Image size 2352x1568: 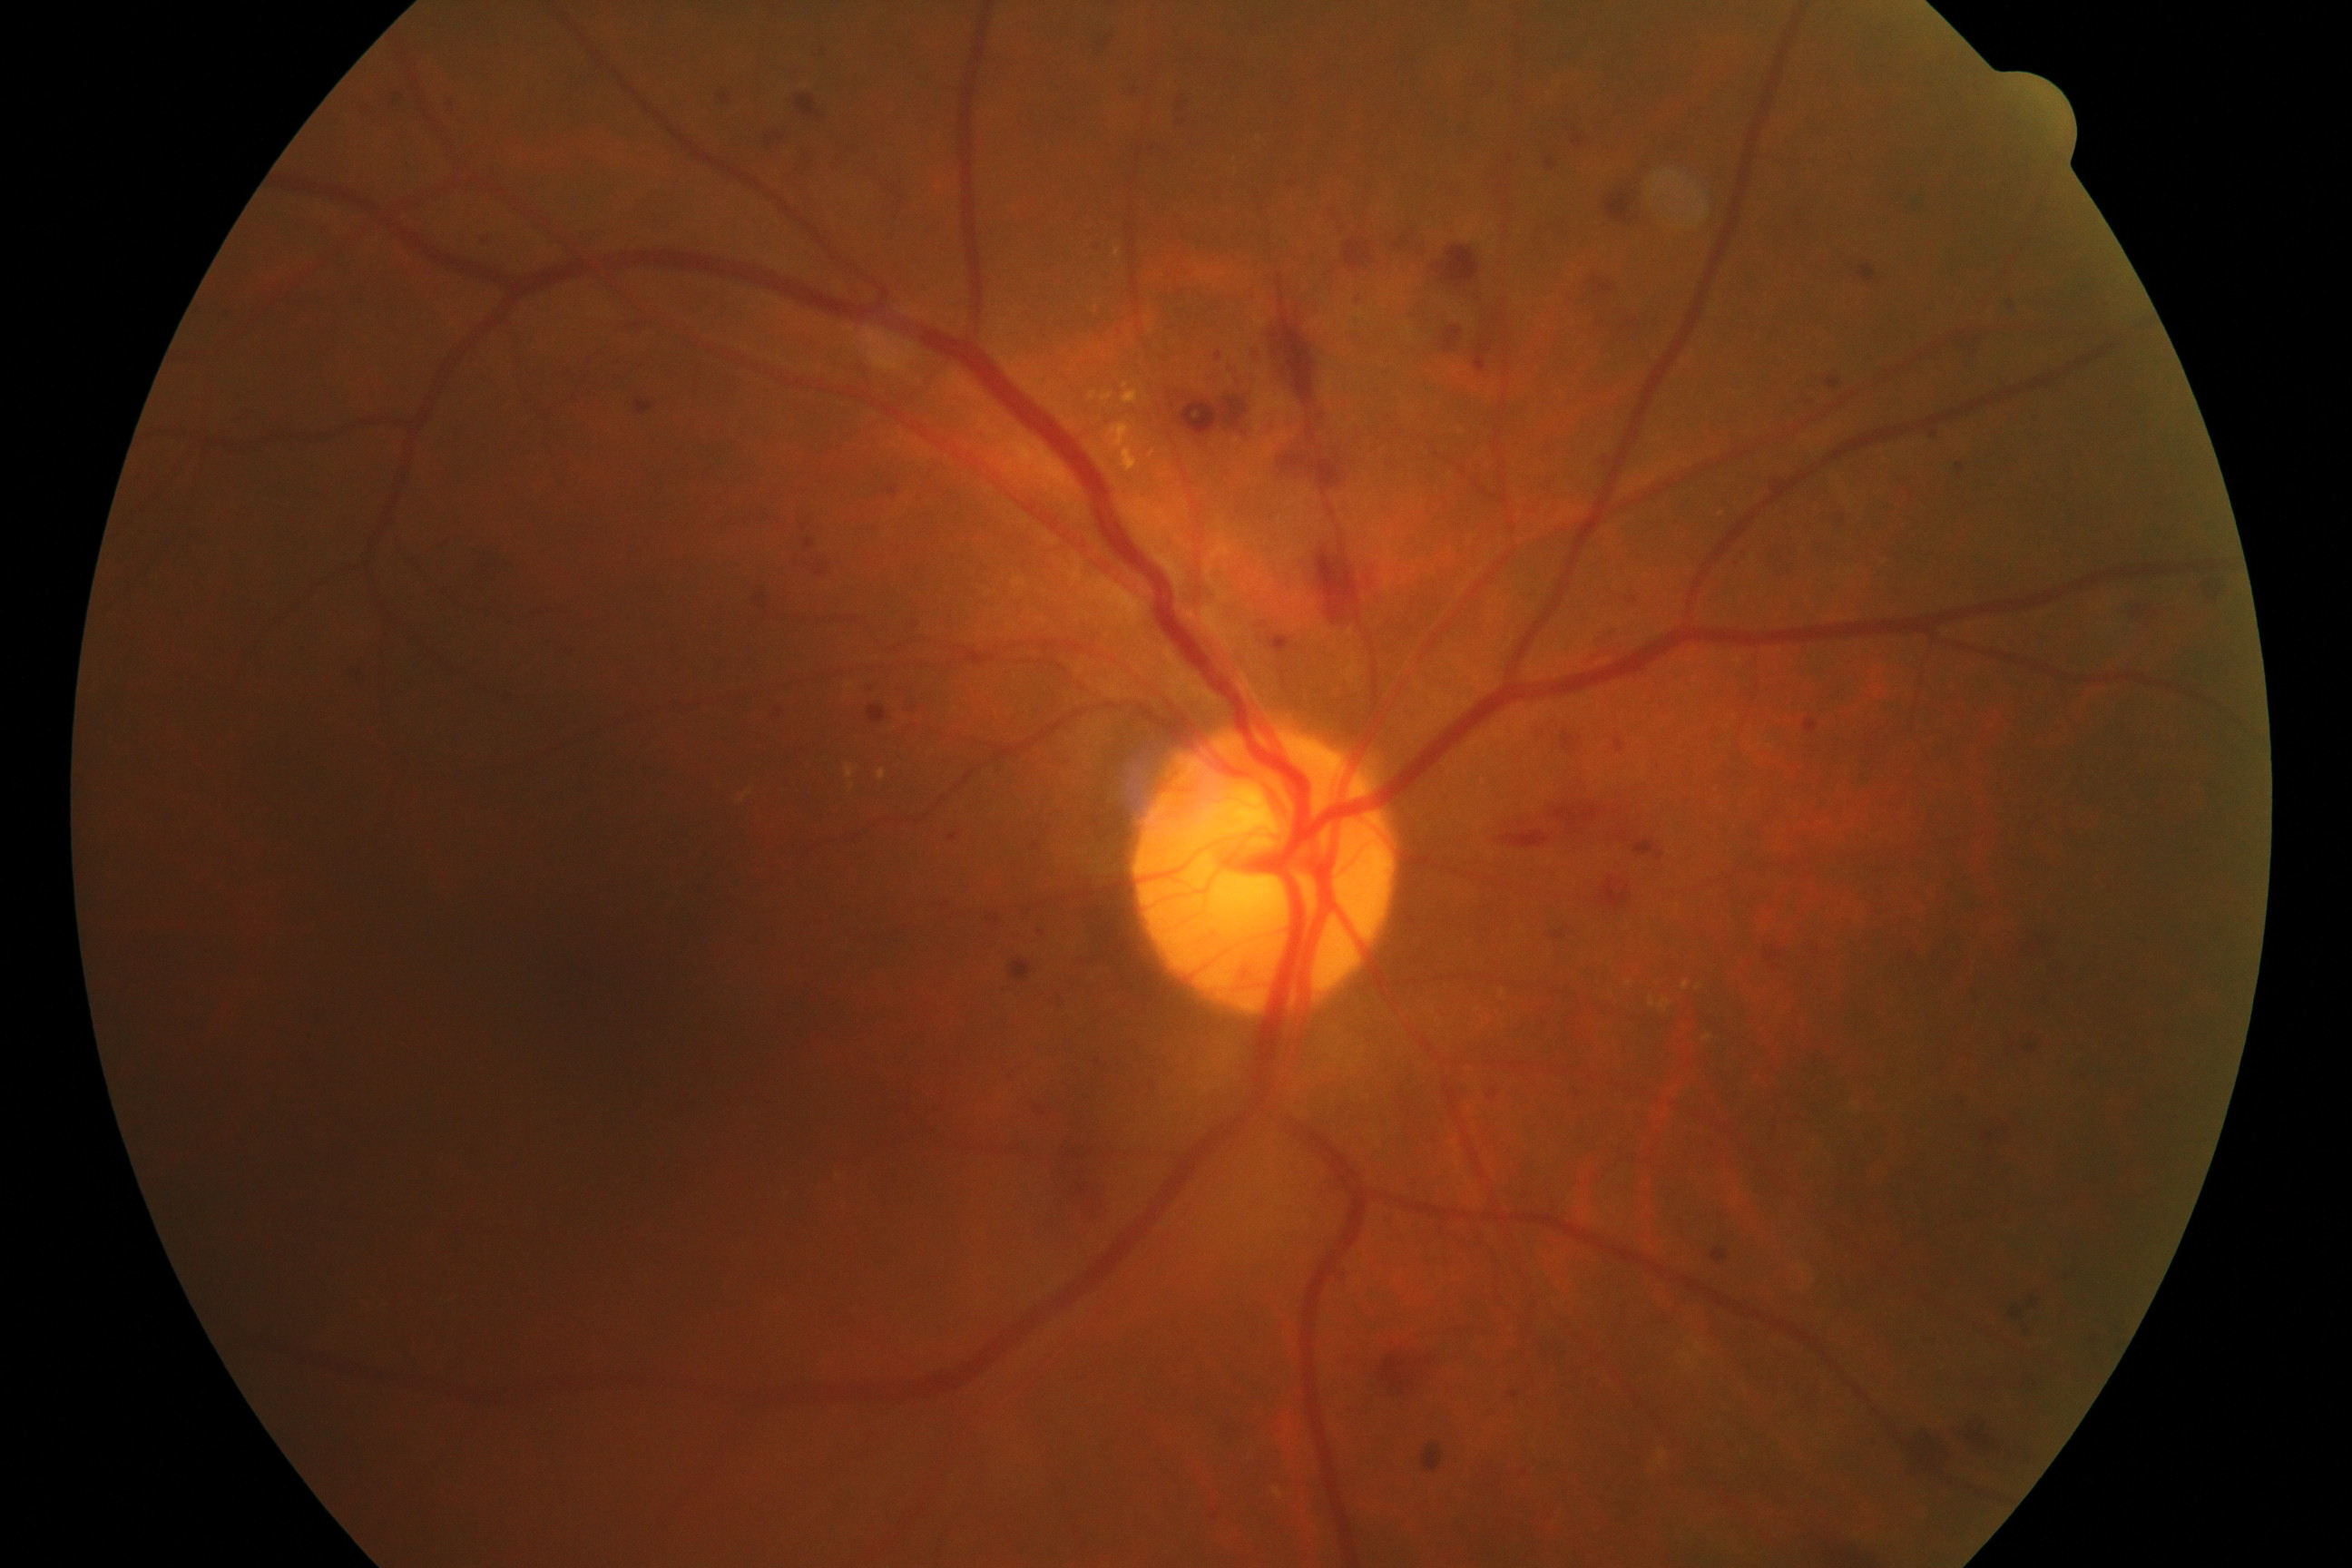
Impression: moderate non-proliferative diabetic retinopathy.